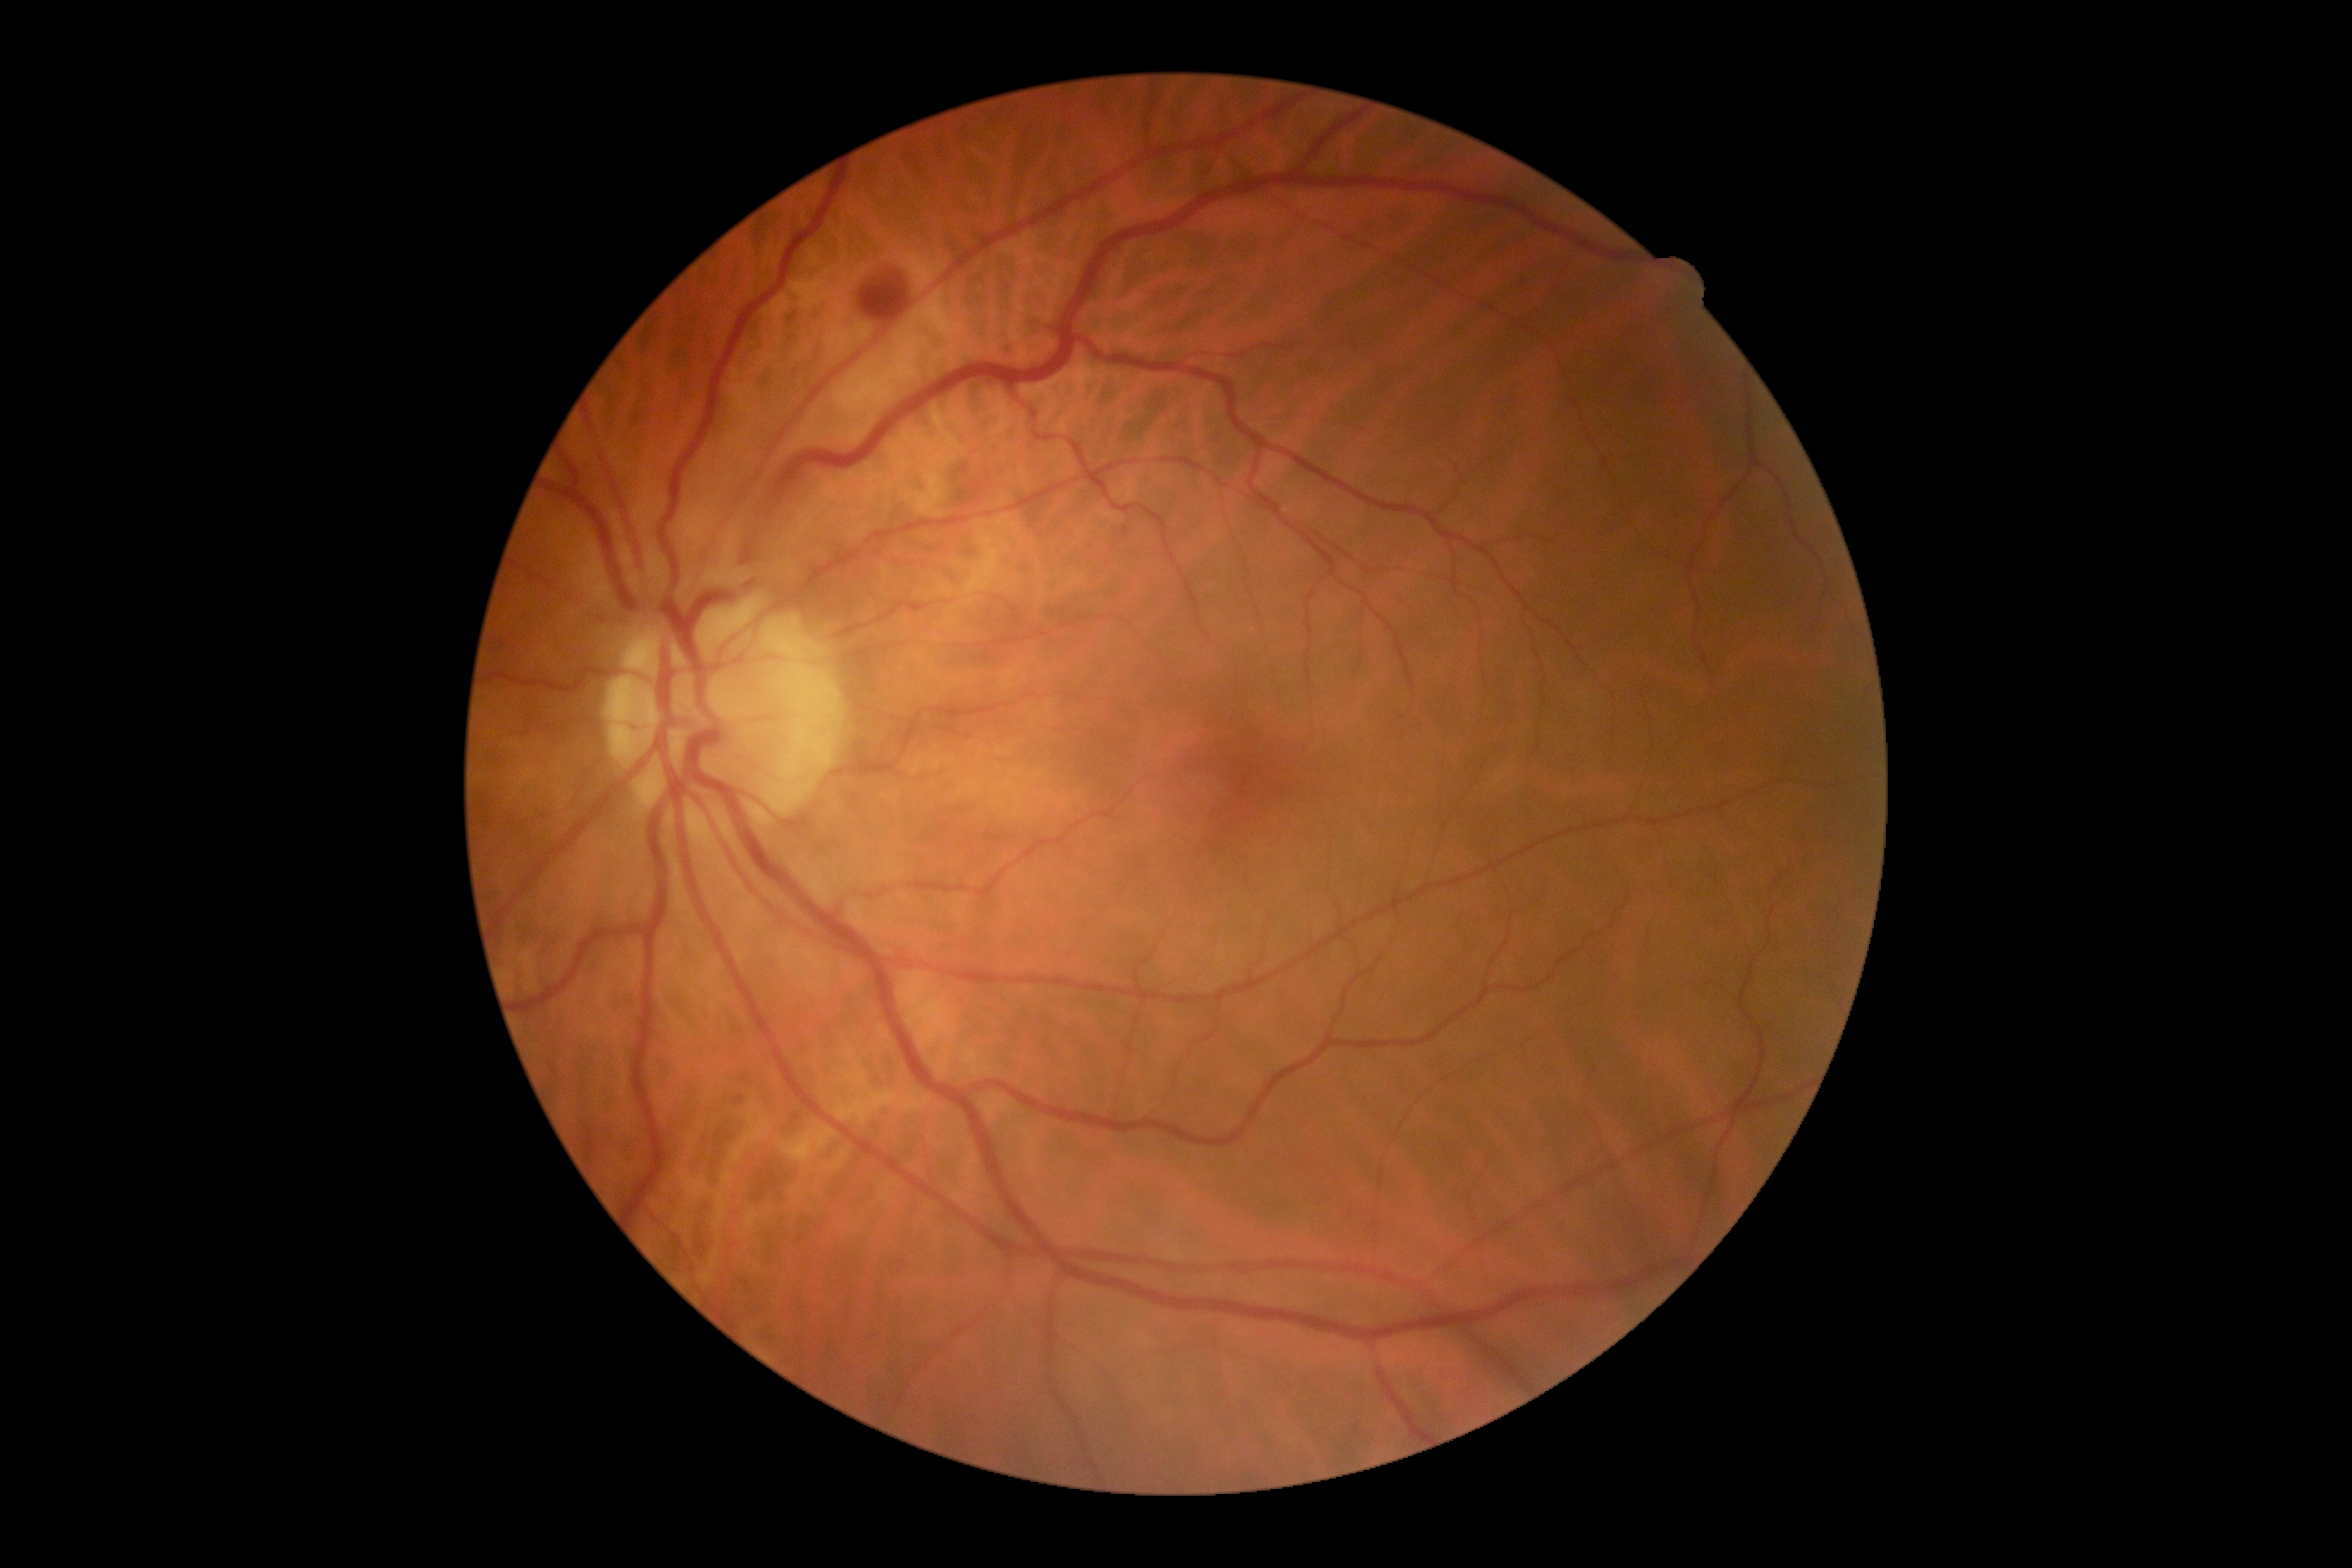

retinopathy = 2/4.